Image size 2352x1568, fundus photo: 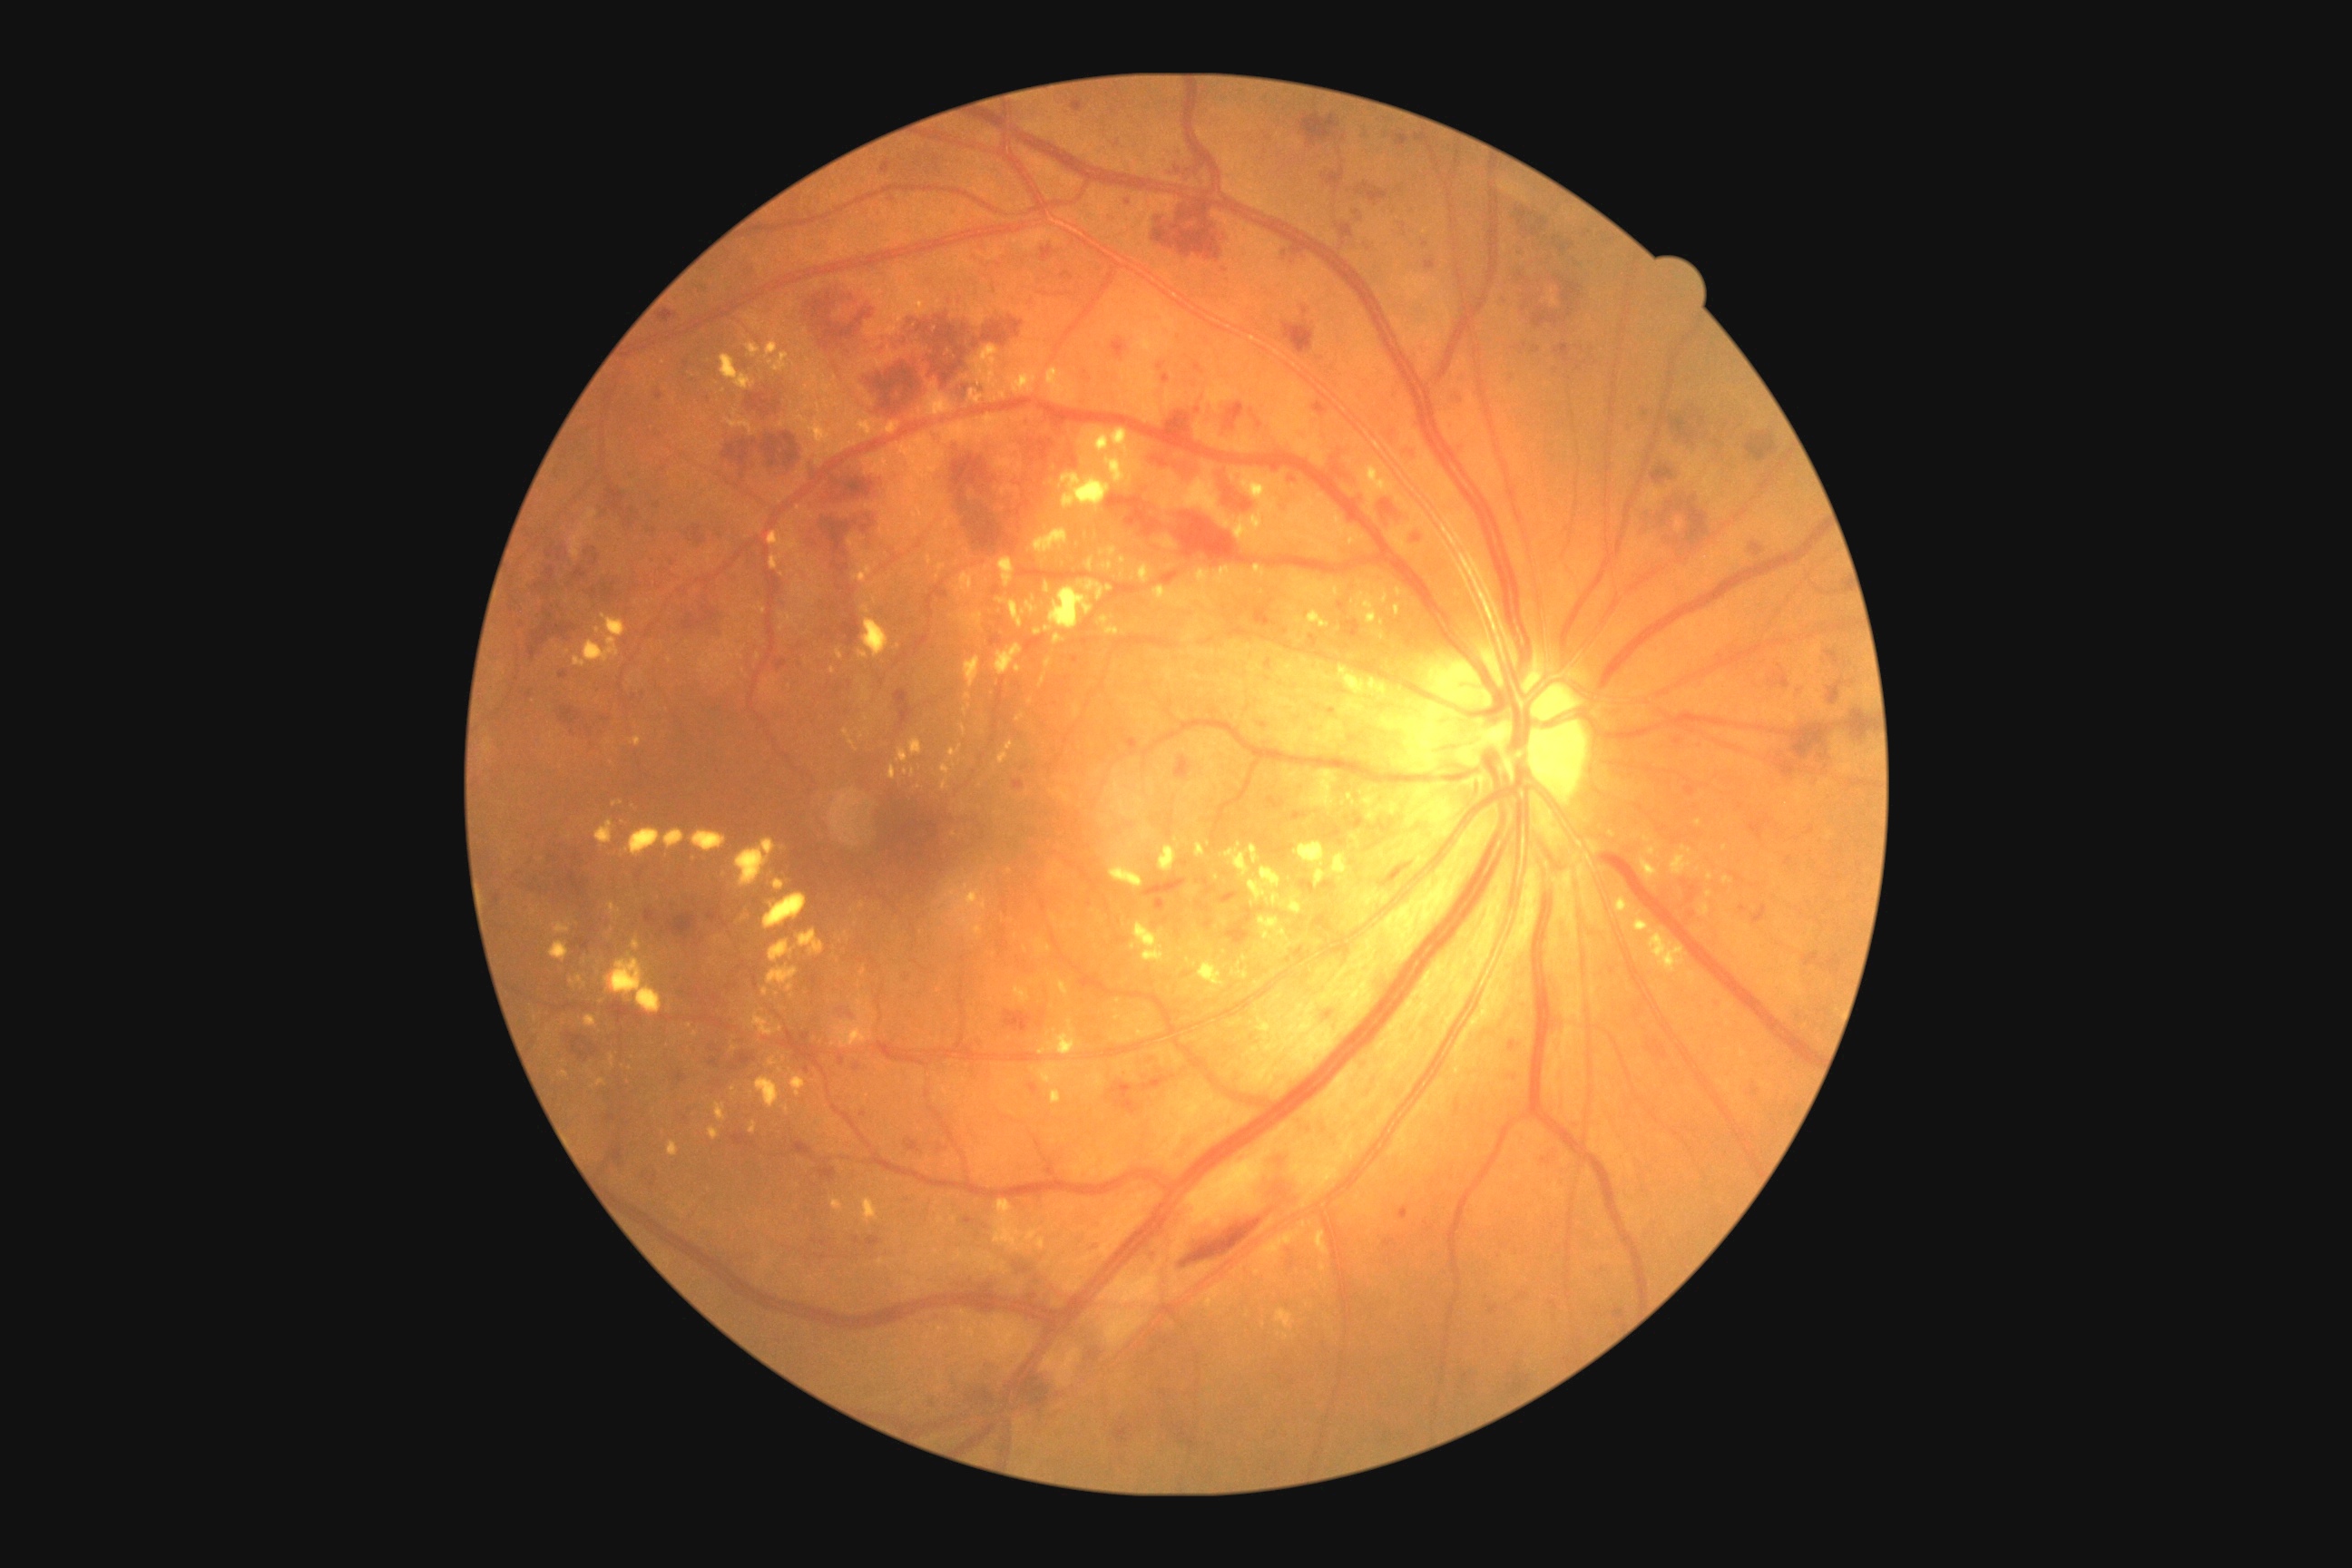 DR severity is severe non-proliferative diabetic retinopathy (grade 3); non-proliferative diabetic retinopathy. SEs identified at (left=1291, top=1132, right=1358, bottom=1208), (left=1186, top=1150, right=1271, bottom=1226). HEs include lesions at (left=560, top=705, right=582, bottom=725), (left=1153, top=411, right=1193, bottom=442), (left=1745, top=433, right=1779, bottom=464), (left=591, top=554, right=600, bottom=567), (left=805, top=514, right=883, bottom=558), (left=845, top=585, right=856, bottom=607), (left=854, top=1237, right=863, bottom=1246), (left=1003, top=1010, right=1035, bottom=1034), (left=894, top=691, right=916, bottom=732), (left=1645, top=1037, right=1669, bottom=1059), (left=743, top=259, right=756, bottom=284), (left=1770, top=723, right=1836, bottom=761), (left=1015, top=496, right=1032, bottom=518), (left=805, top=291, right=1024, bottom=404), (left=865, top=1237, right=881, bottom=1250), (left=1141, top=1075, right=1175, bottom=1092), (left=1511, top=1041, right=1520, bottom=1048), (left=1142, top=876, right=1188, bottom=914). Small HEs approximately at x=567, y=554, x=844, y=299. MAs include lesions at (left=1072, top=656, right=1079, bottom=665), (left=1014, top=779, right=1026, bottom=790), (left=524, top=691, right=533, bottom=701), (left=730, top=1133, right=758, bottom=1148), (left=1785, top=858, right=1792, bottom=867), (left=1749, top=814, right=1774, bottom=843), (left=905, top=1137, right=923, bottom=1153), (left=1489, top=1304, right=1500, bottom=1315), (left=1462, top=1373, right=1469, bottom=1382), (left=852, top=1063, right=861, bottom=1072), (left=1740, top=905, right=1750, bottom=914), (left=1309, top=634, right=1318, bottom=649), (left=674, top=1072, right=689, bottom=1086), (left=1072, top=97, right=1086, bottom=113), (left=965, top=1217, right=975, bottom=1224), (left=1021, top=765, right=1030, bottom=770), (left=1197, top=903, right=1211, bottom=914). Small MAs approximately at x=933, y=1404, x=573, y=946, x=1178, y=170. EXs include lesions at (left=798, top=930, right=825, bottom=956), (left=714, top=1102, right=727, bottom=1122), (left=1157, top=462, right=1369, bottom=547), (left=858, top=1004, right=872, bottom=1017), (left=1014, top=665, right=1023, bottom=674), (left=861, top=968, right=867, bottom=977), (left=1631, top=917, right=1680, bottom=963), (left=1044, top=658, right=1054, bottom=669), (left=691, top=830, right=727, bottom=854), (left=576, top=975, right=587, bottom=986), (left=549, top=941, right=569, bottom=963), (left=970, top=346, right=1001, bottom=389), (left=1035, top=1237, right=1046, bottom=1251), (left=1034, top=629, right=1043, bottom=636), (left=999, top=741, right=1014, bottom=765), (left=1164, top=669, right=1168, bottom=680). Small EXs approximately at x=1033, y=600, x=781, y=1071, x=954, y=766, x=1084, y=463.